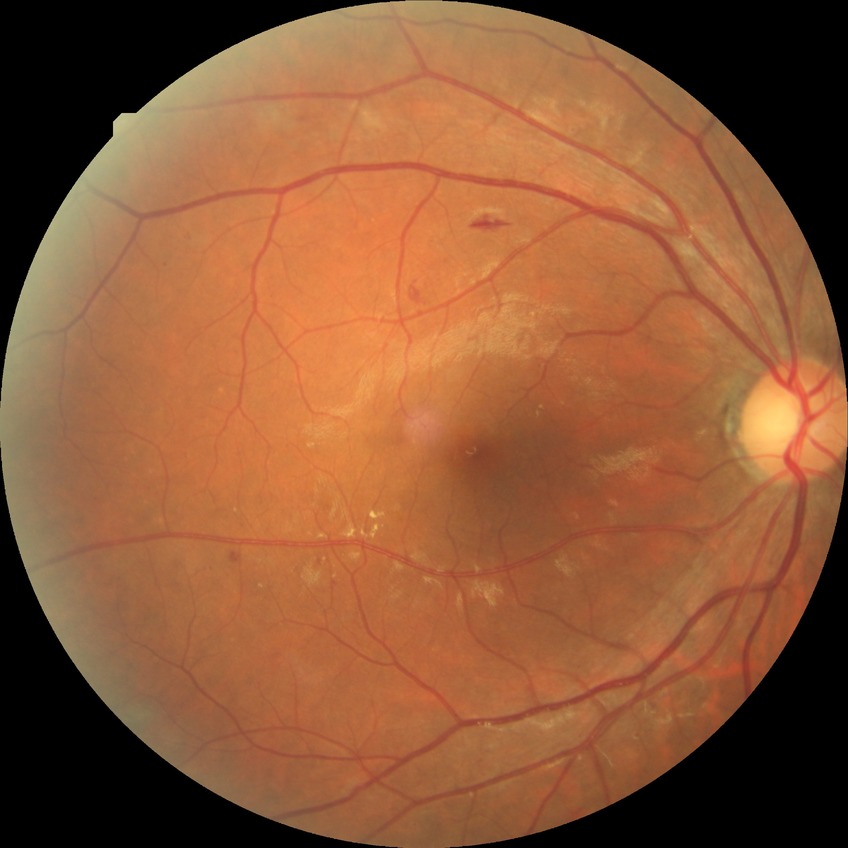

  davis_grade: SDR